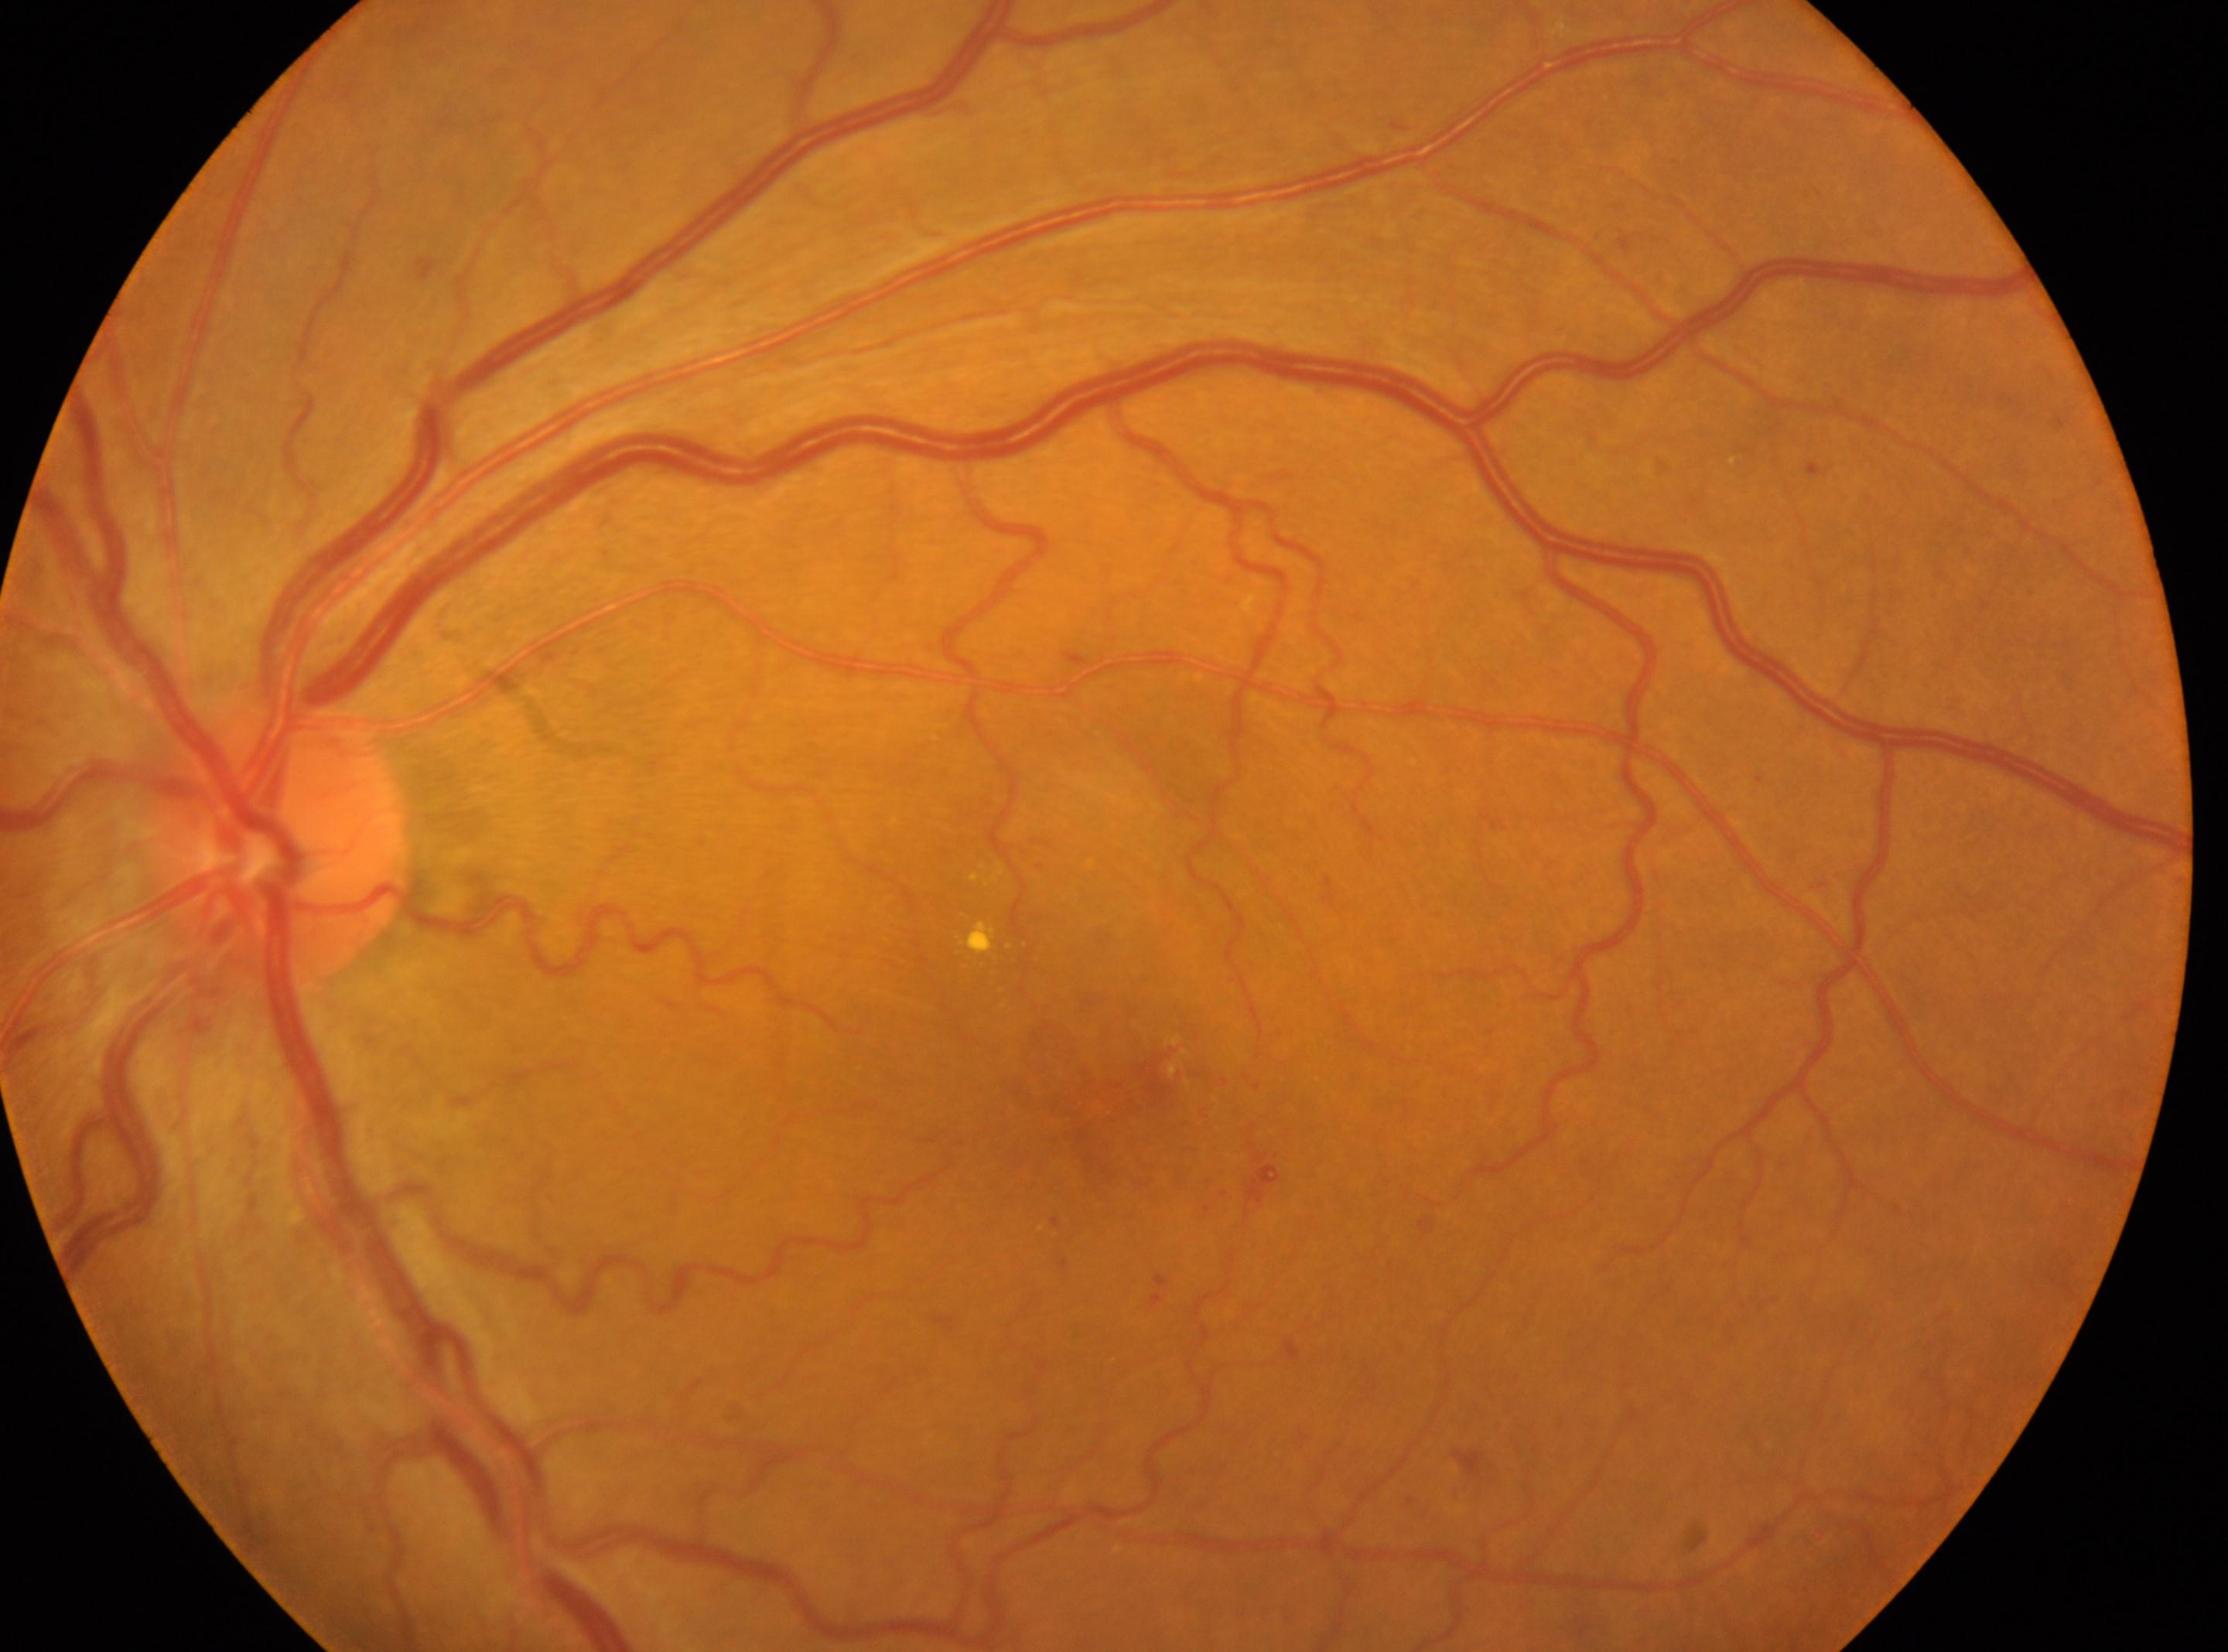 Findings:
- optic disk · 275px, 845px
- DR · moderate NPDR (grade 2)
- laterality · left eye
- macula center · 1106px, 1108px